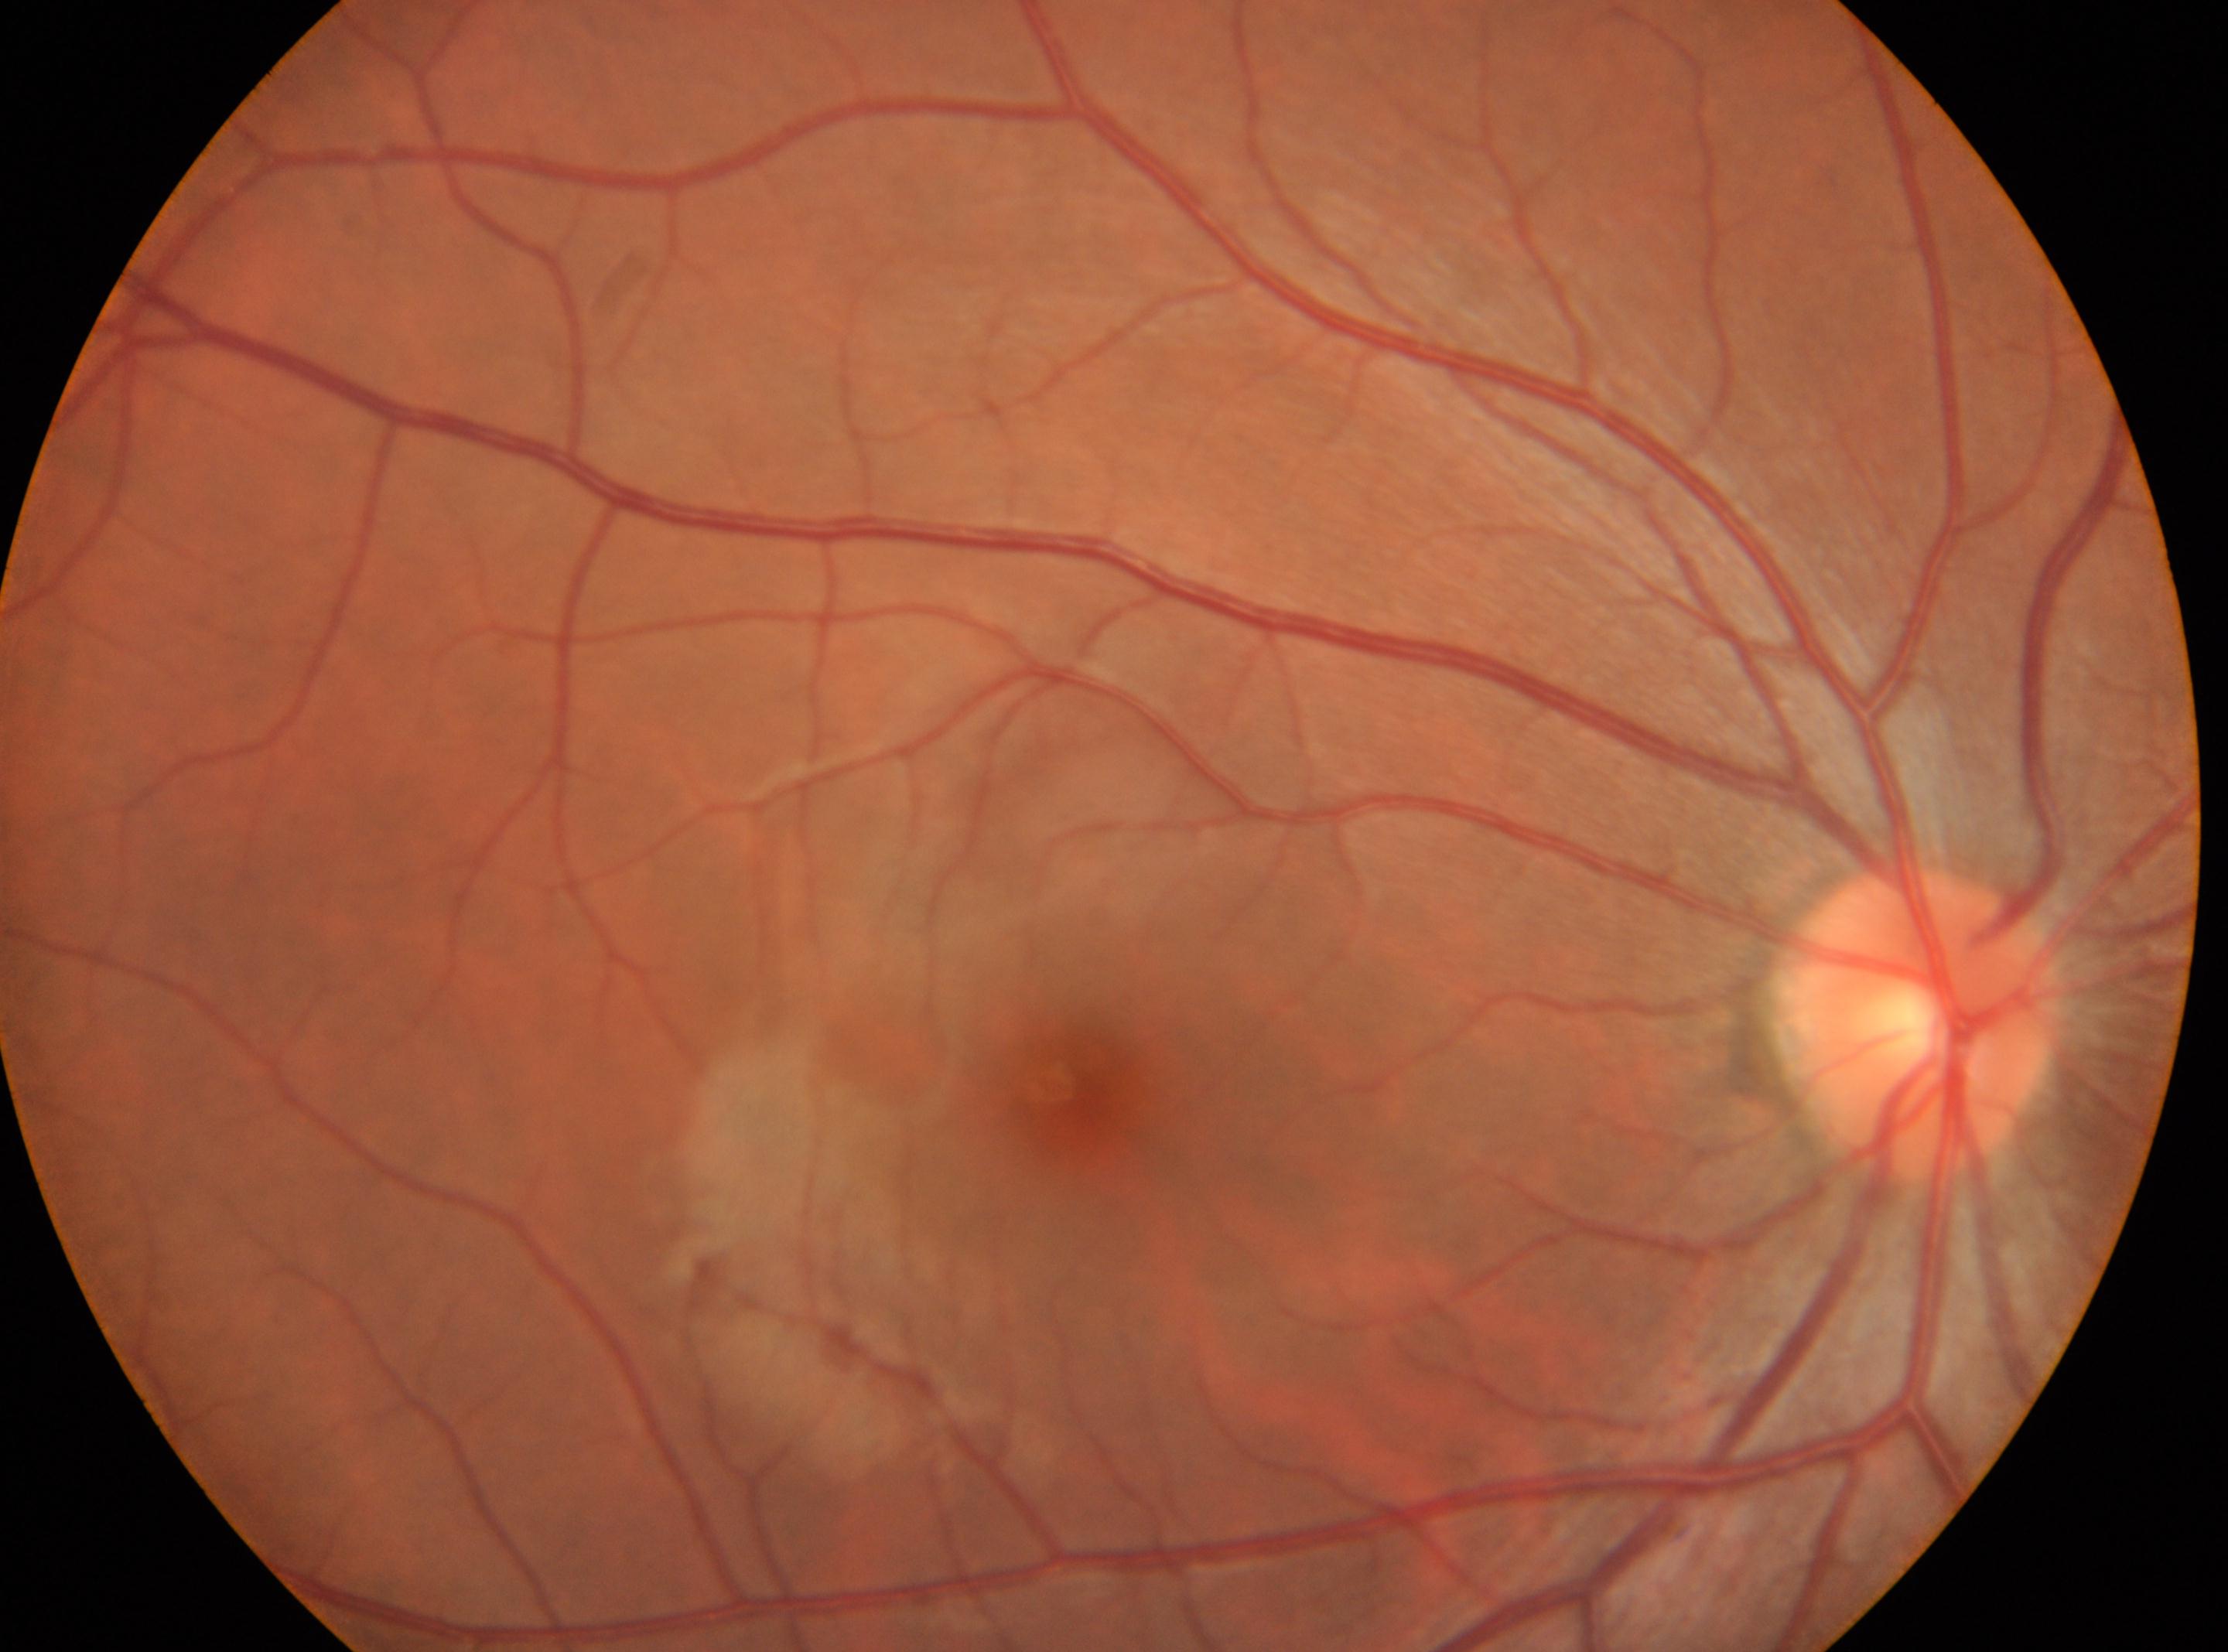
DR is grade 0. This is the OD. Optic disc: (x=1922, y=1021). Macula center: (x=1071, y=1086).